Posterior pole photograph.
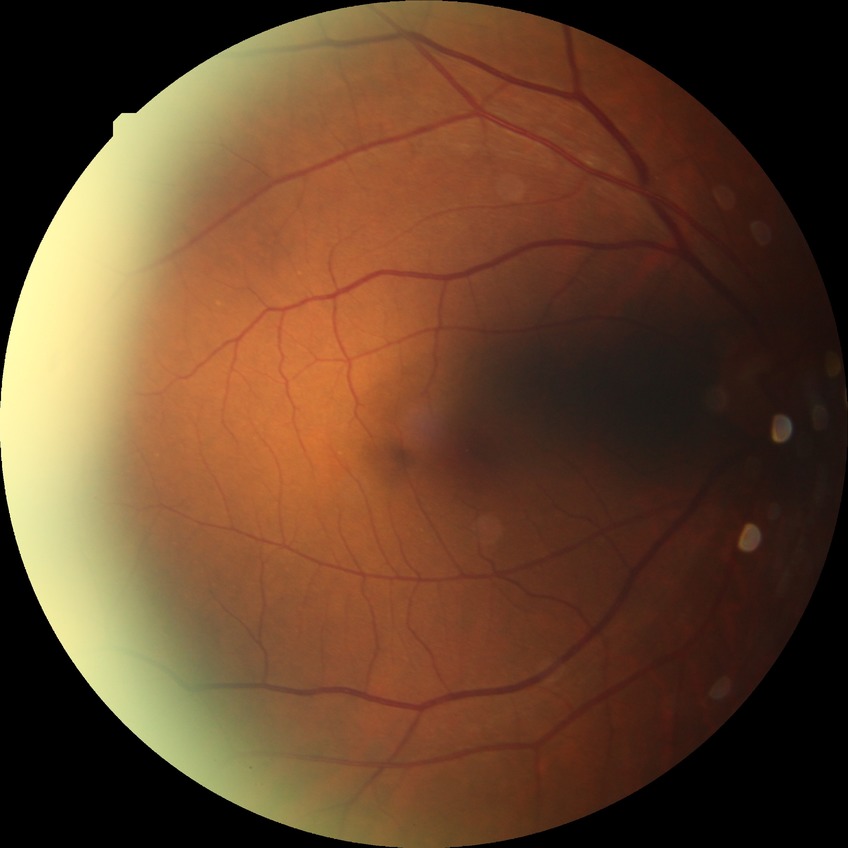 Diabetic retinopathy (DR): no diabetic retinopathy (NDR).